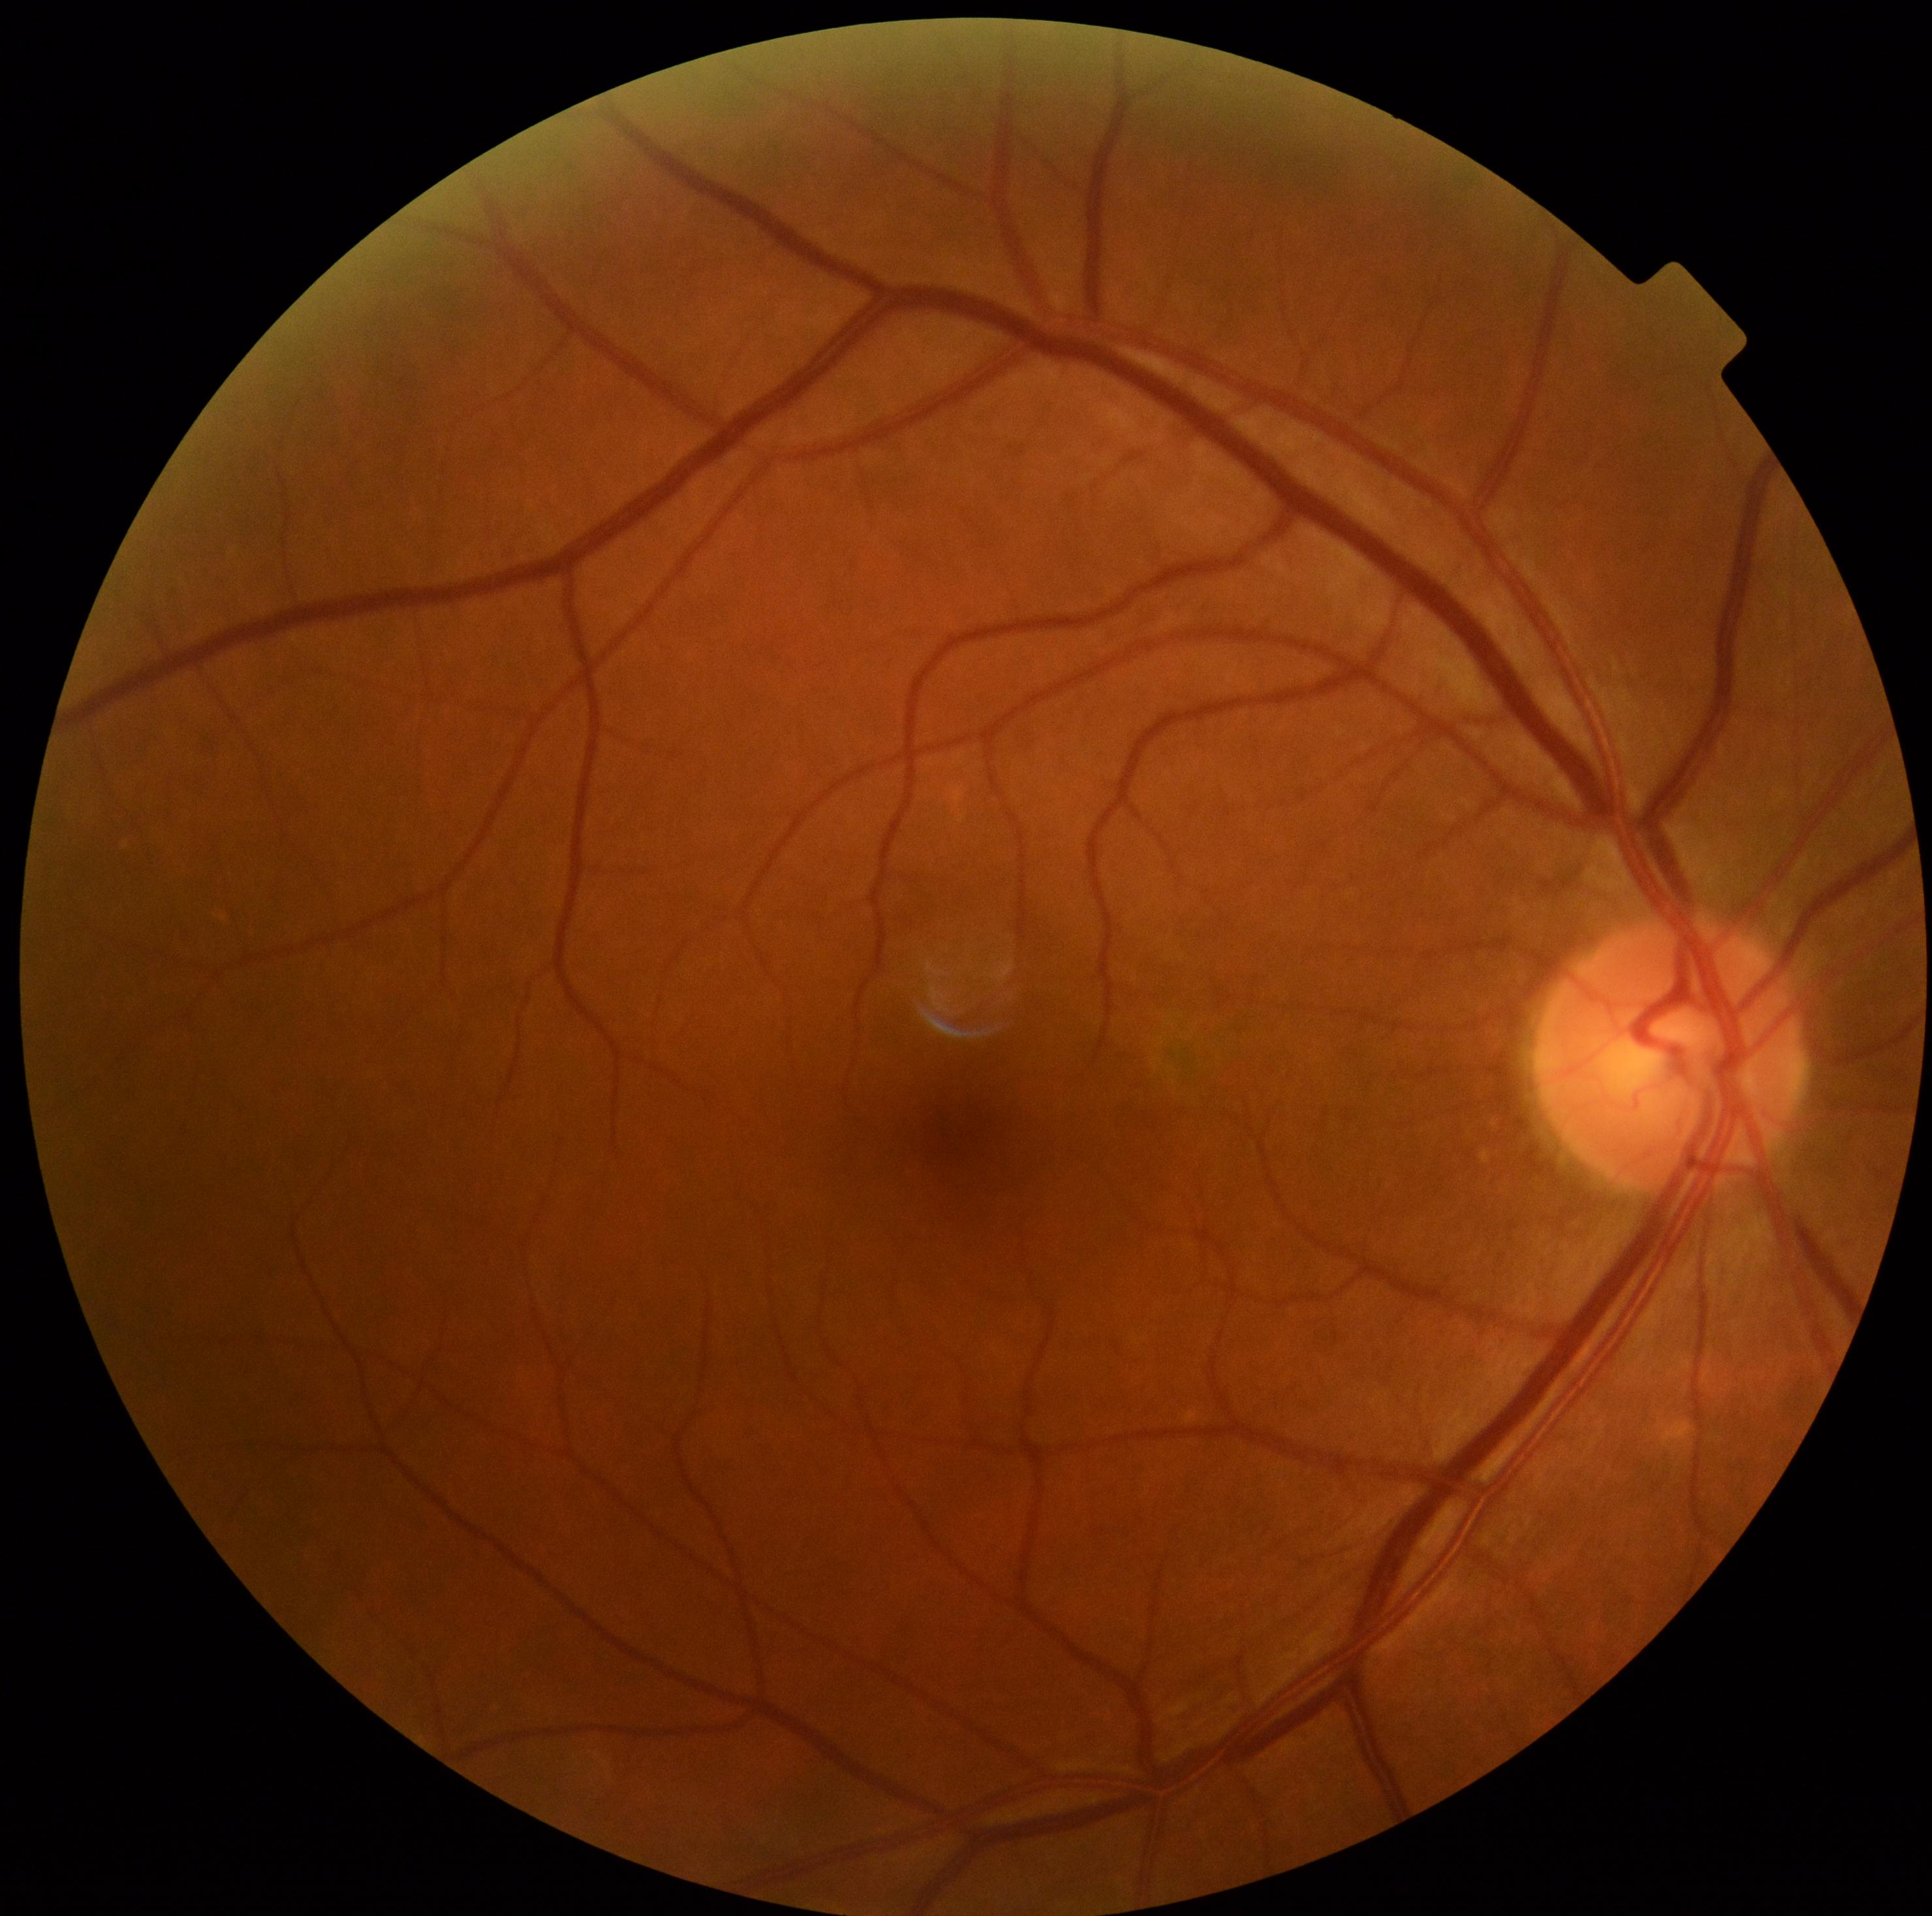 dr_grade: grade 0